Captured after pupil dilation · centered on the macula · captured on a Kowa VX-10α fundus camera — 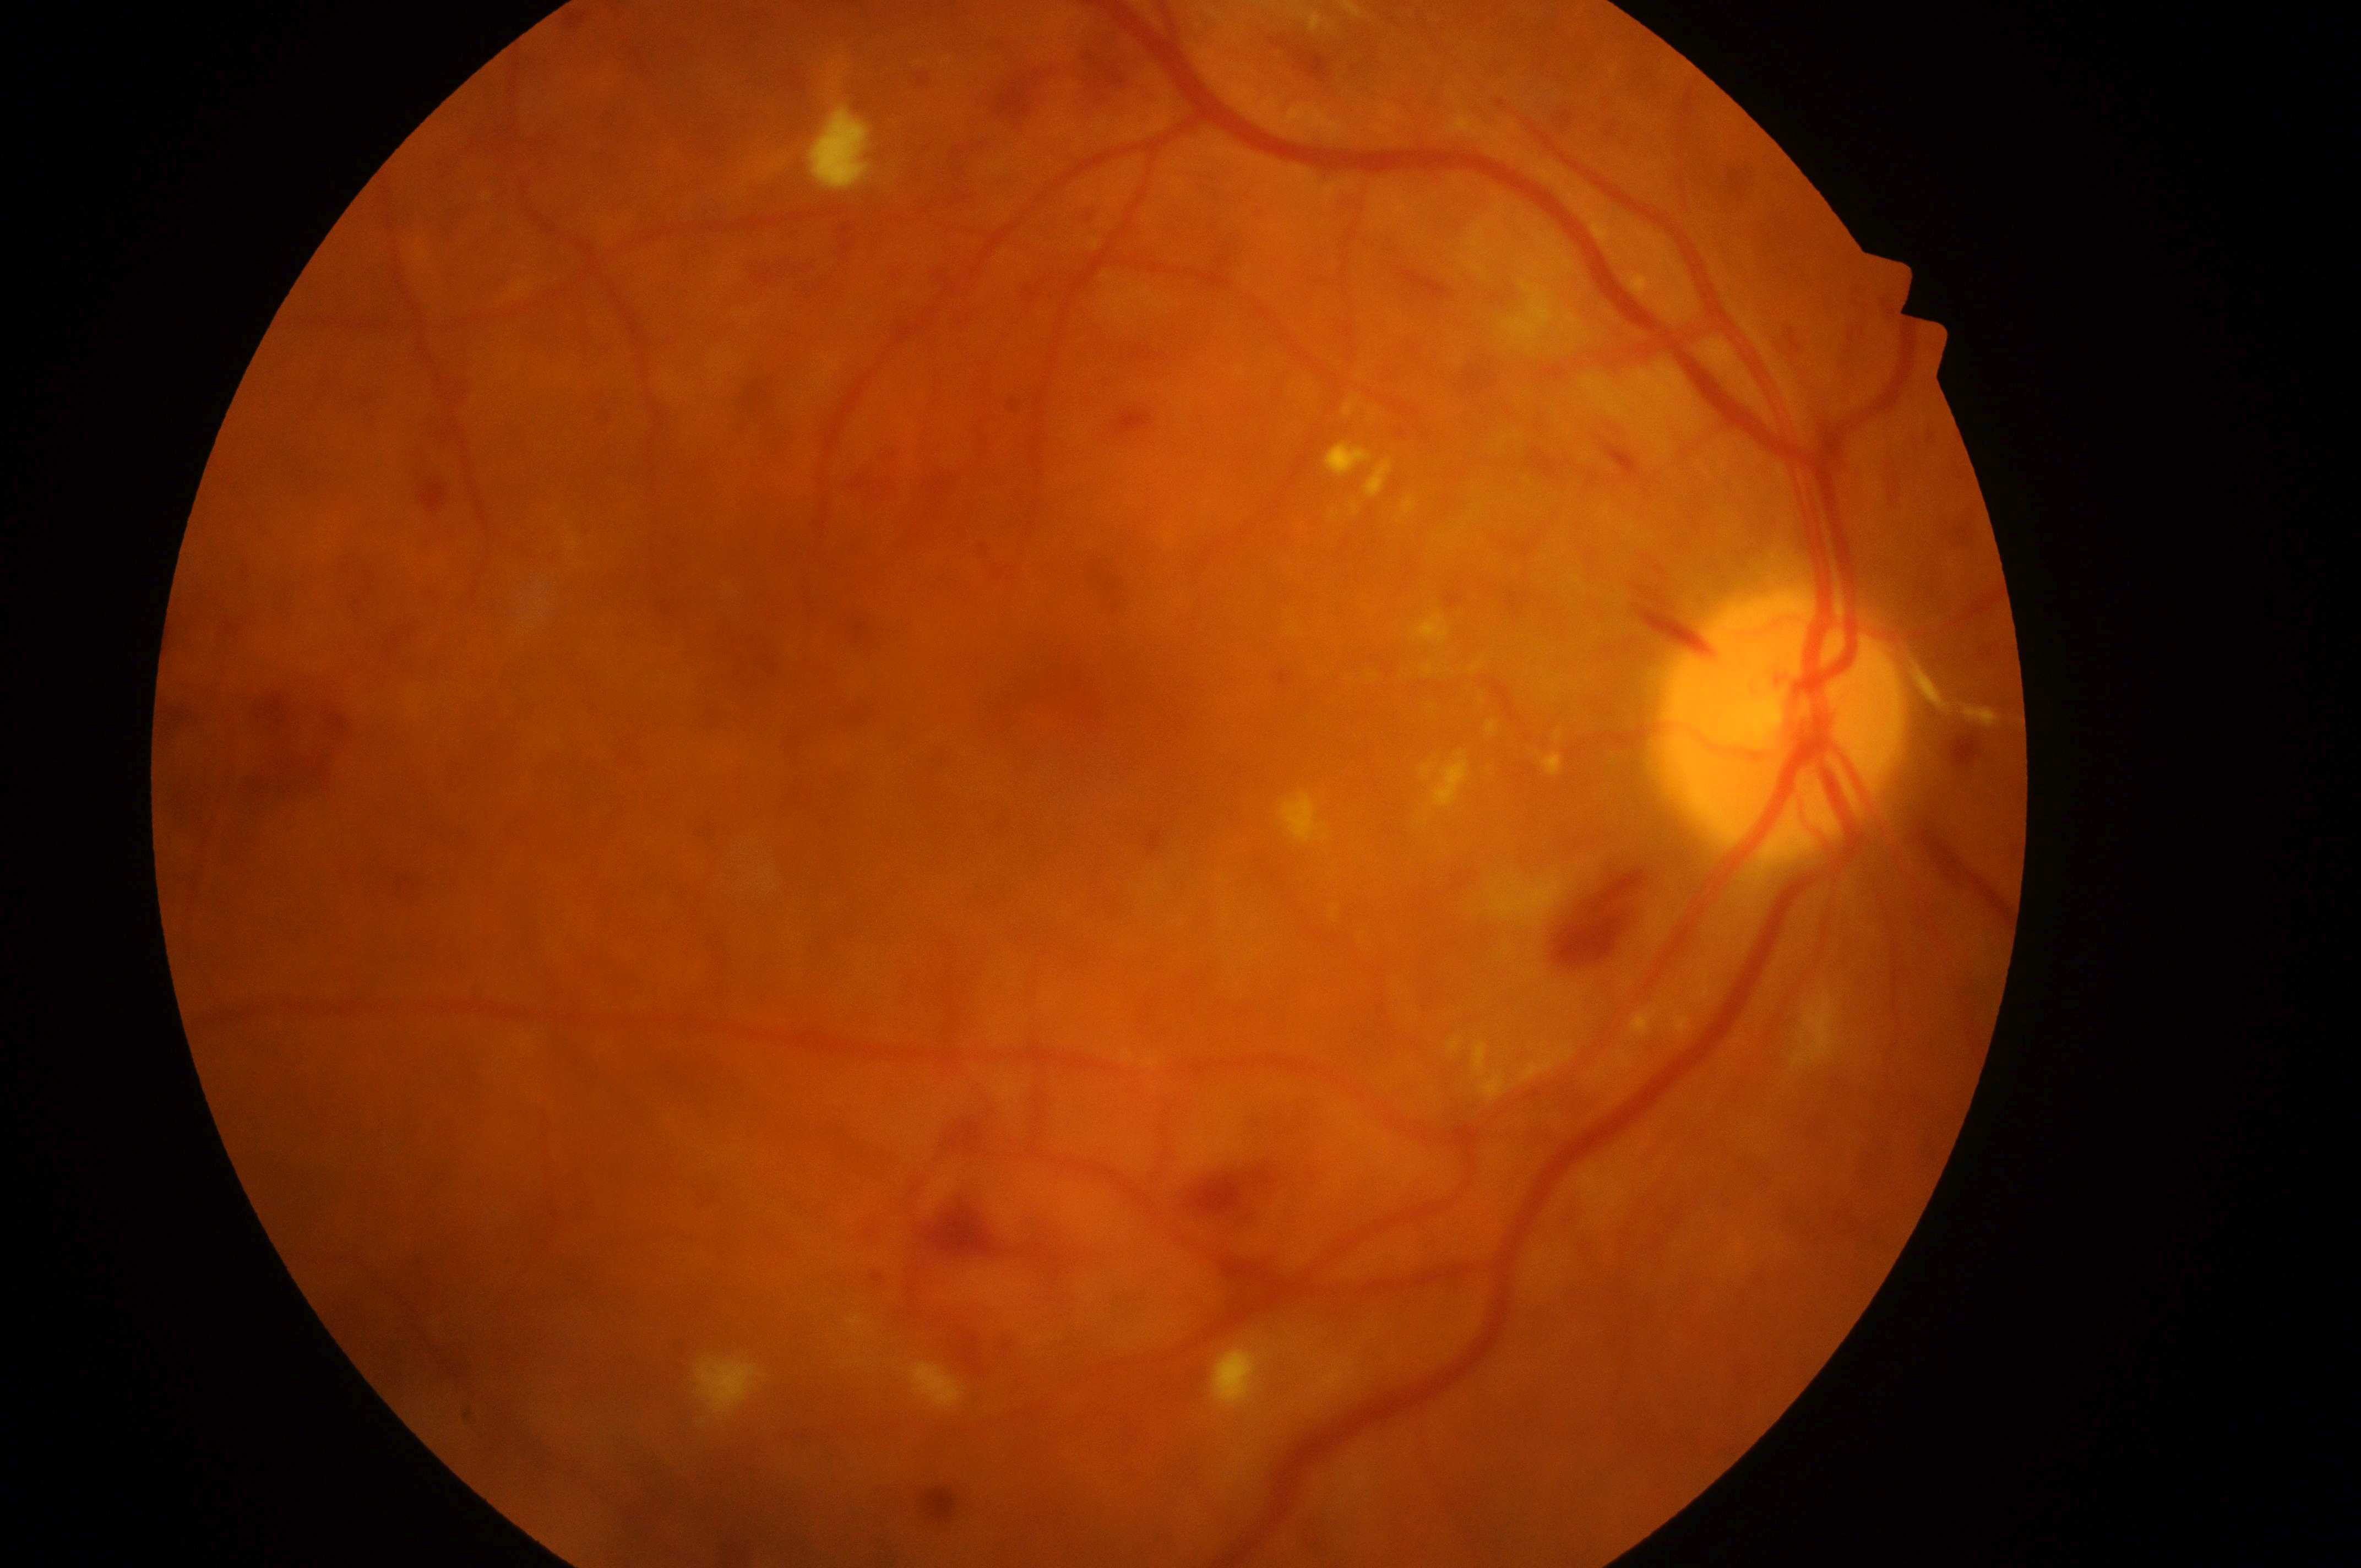

fovea center: (1067,709)
laterality: the right eye
optic disc center: (1785,729)
DR class: non-proliferative diabetic retinopathy
DR grade: 3 (severe NPDR)
DME grade: high risk (2)